1924 x 1556 pixels · UWF retinal mosaic: 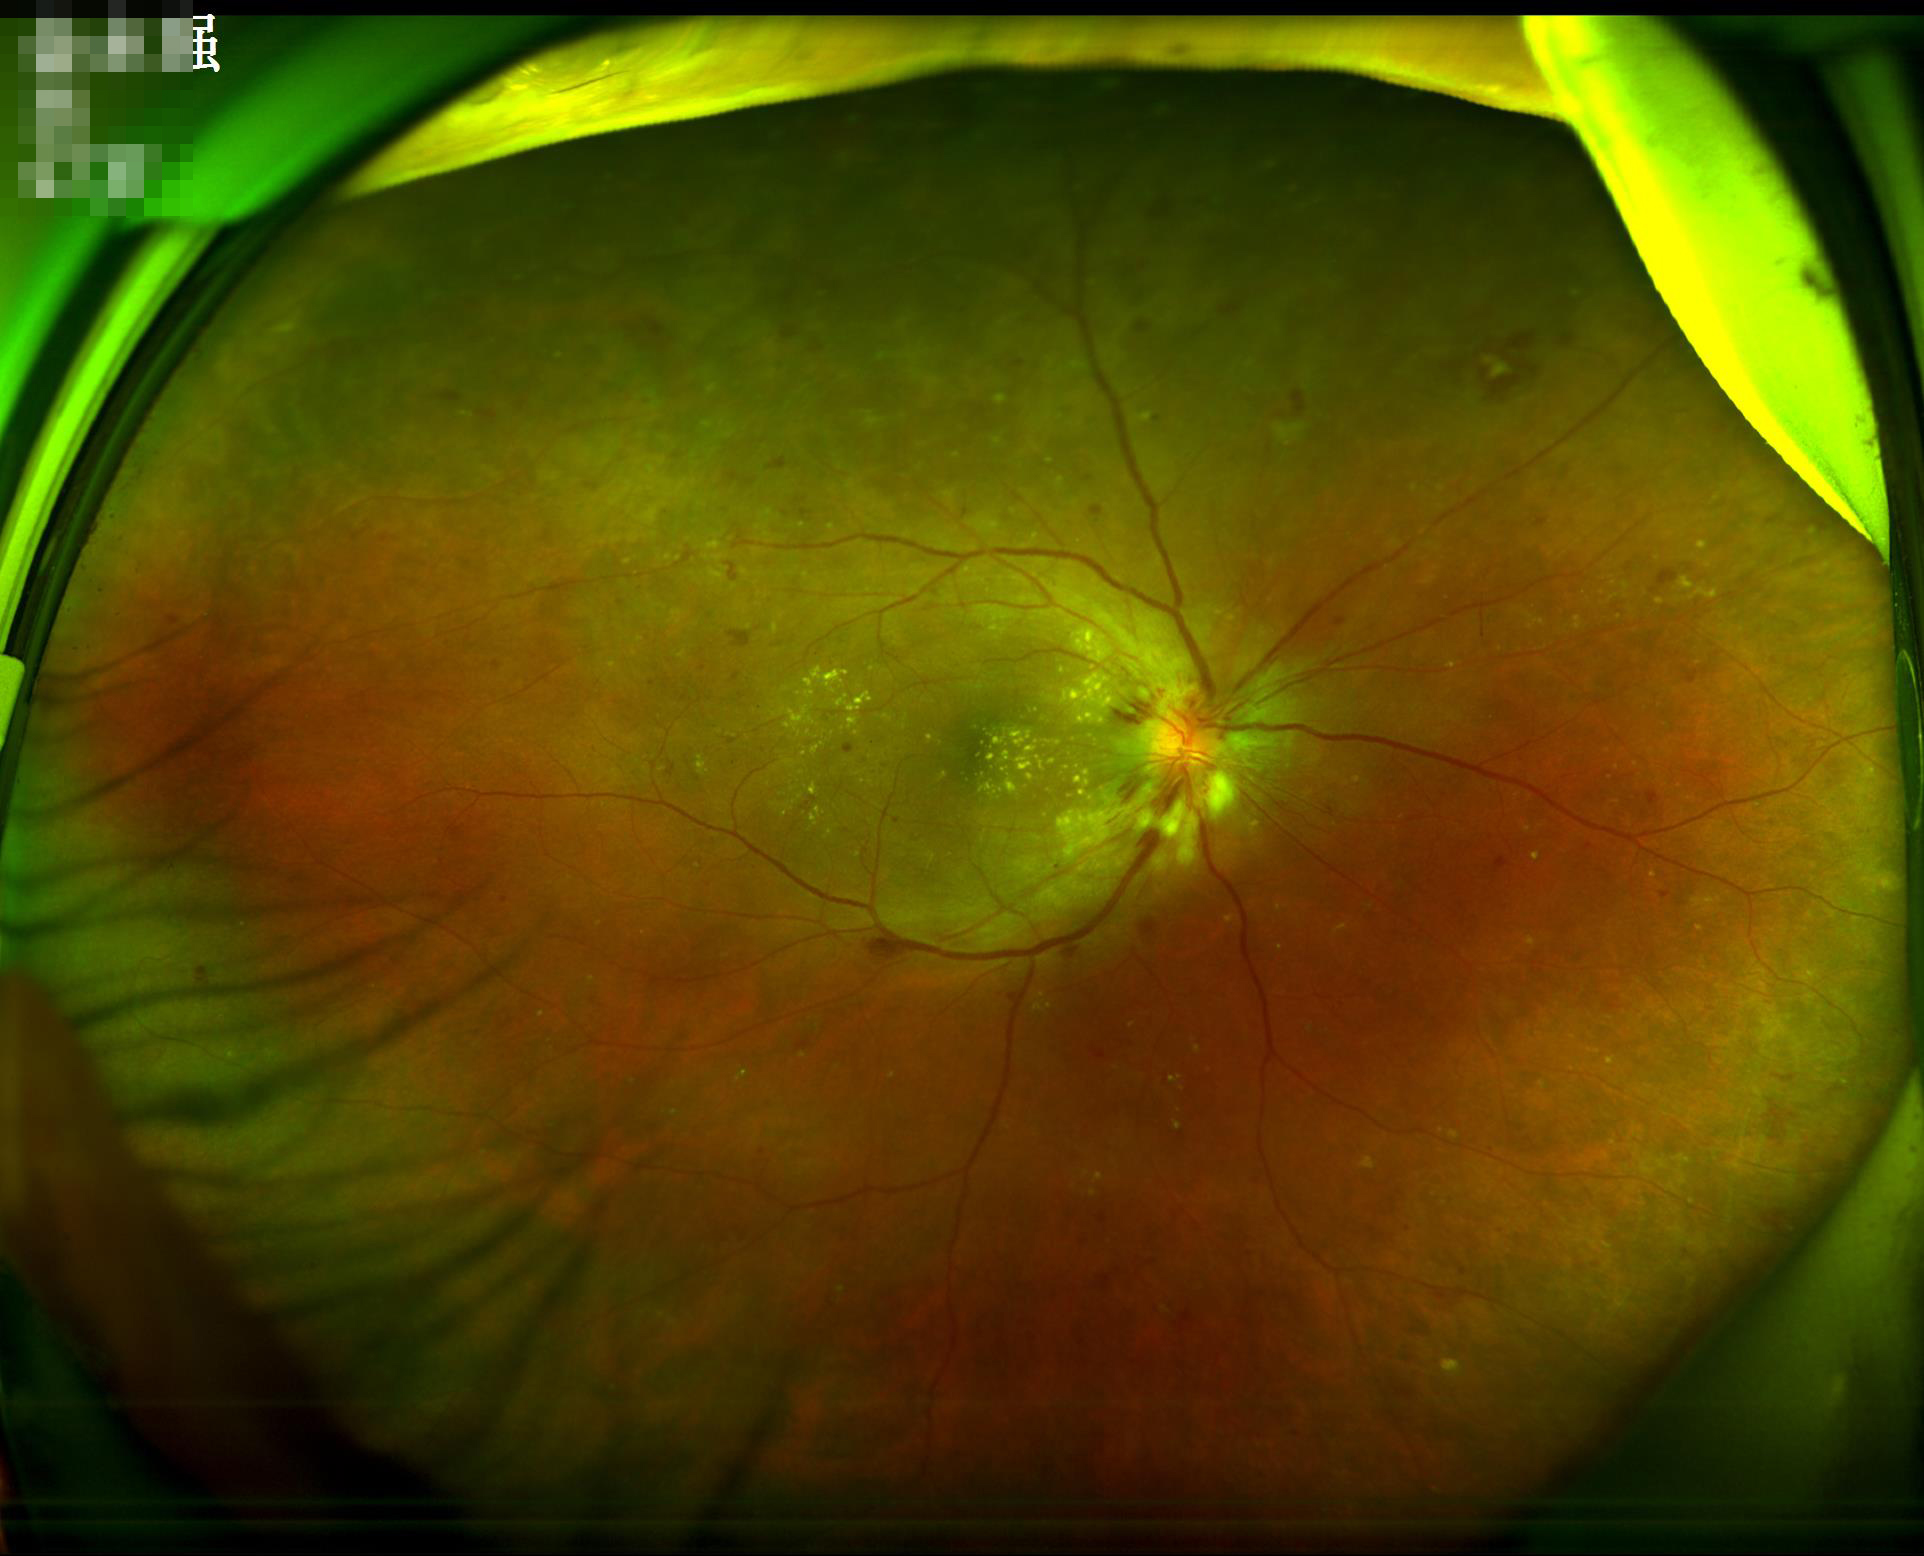
Quality assessment: illumination: even and well-balanced | contrast: good dynamic range.